2048x1536
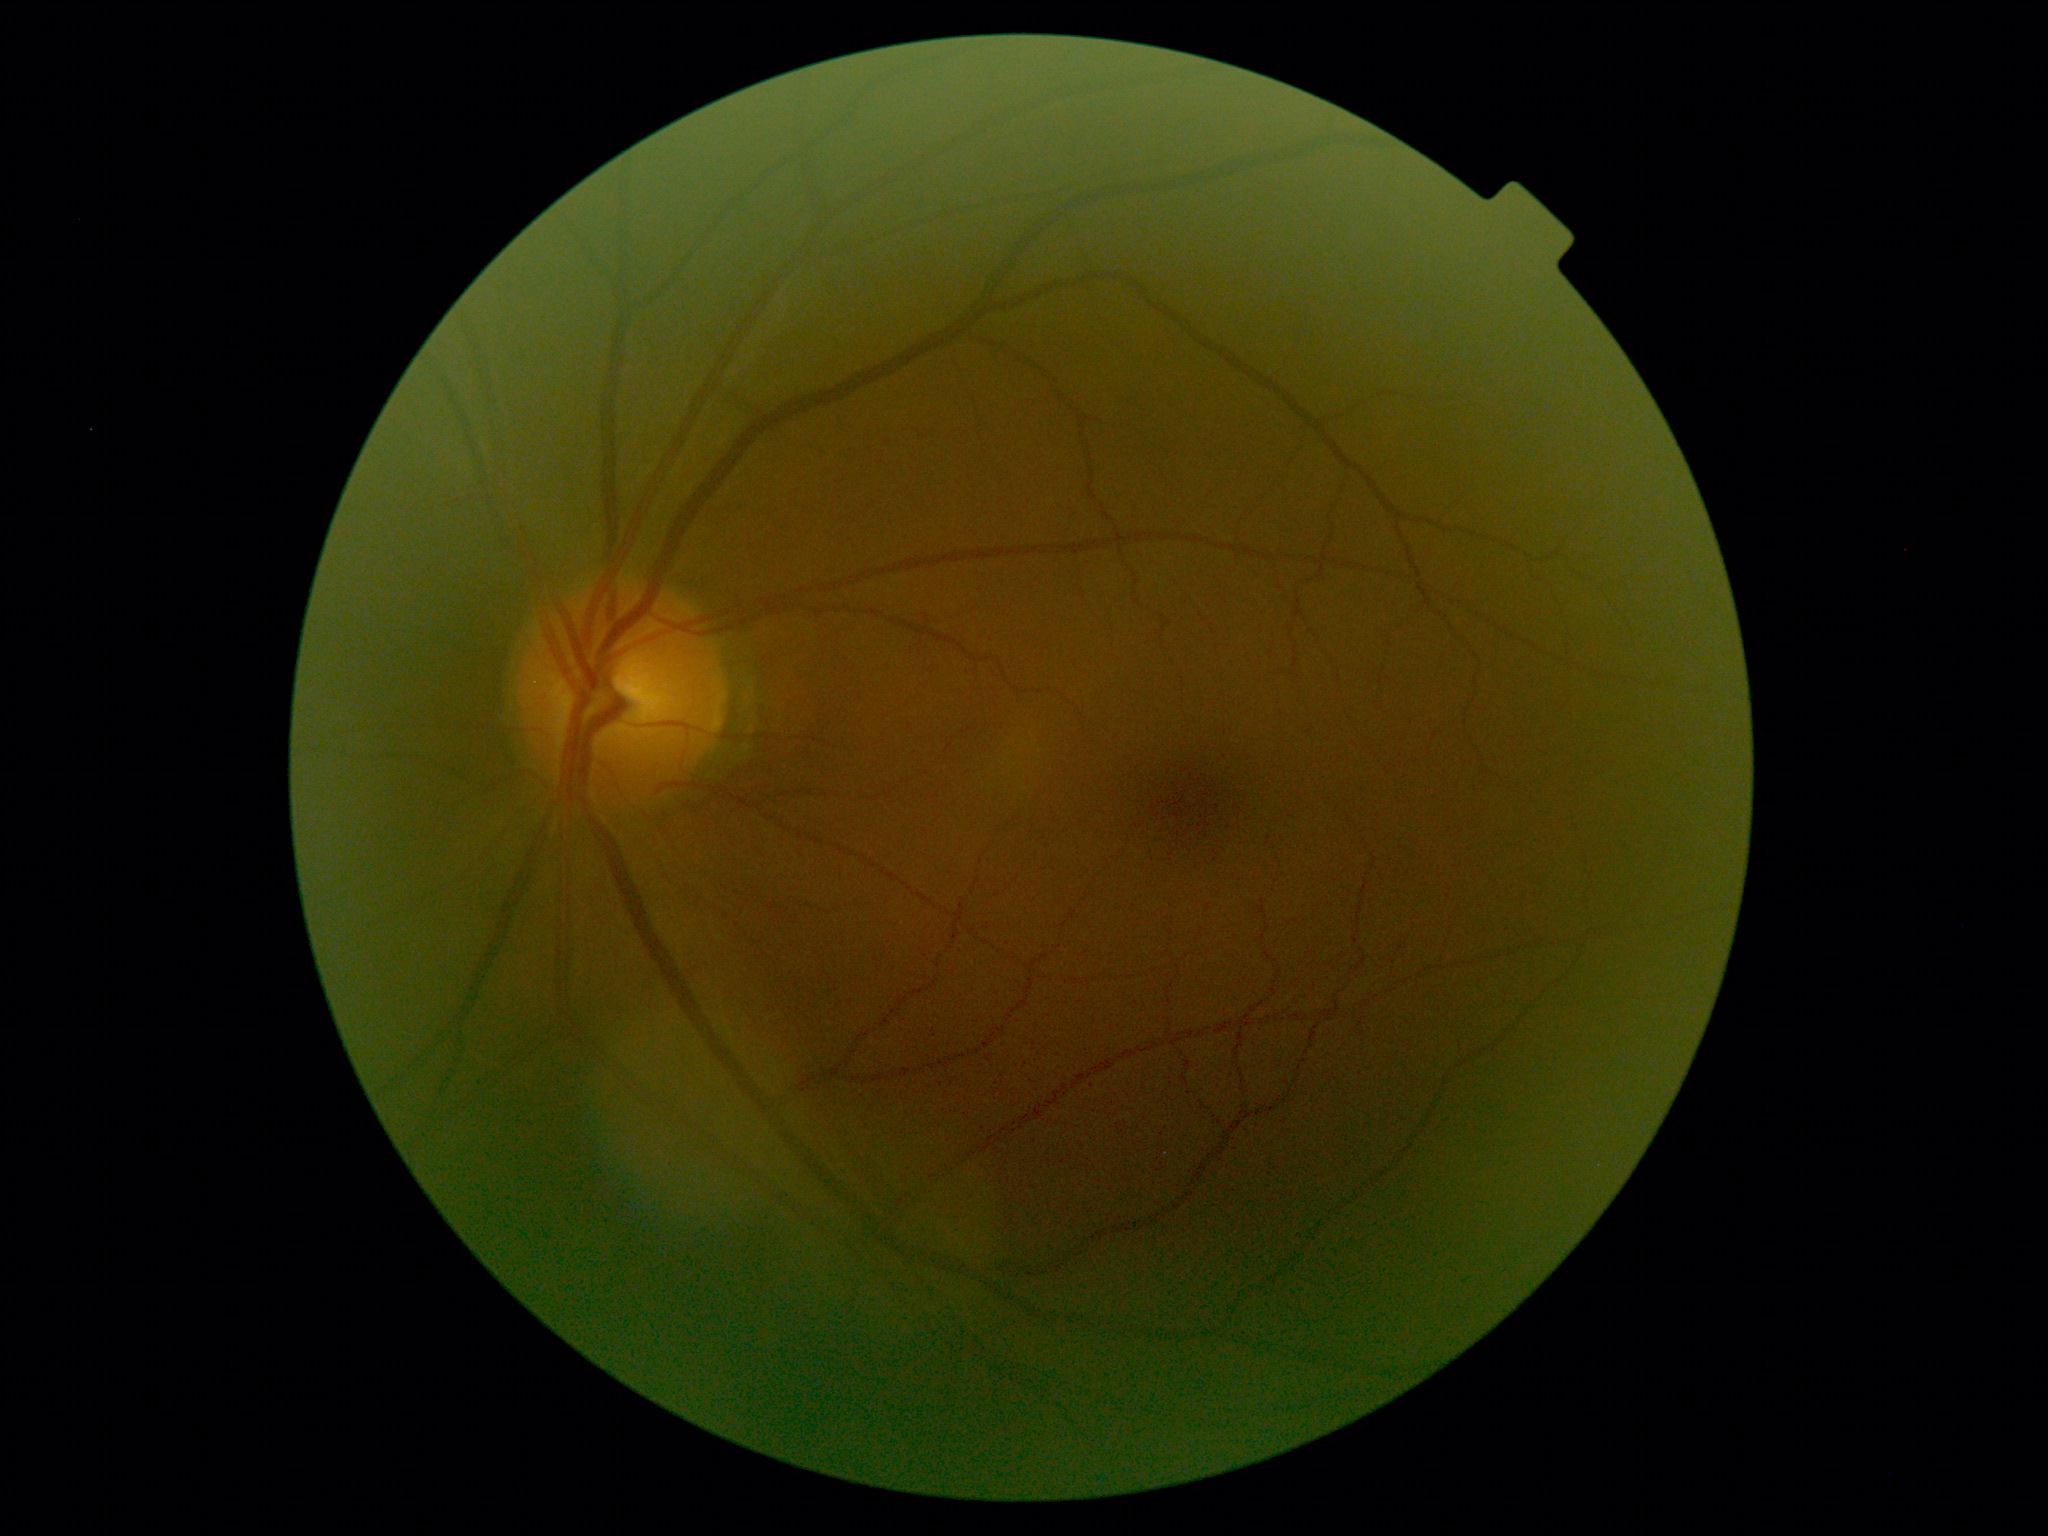
diabetic retinopathy = grade 0 (no apparent retinopathy).